Wide-field retinal mosaic image.
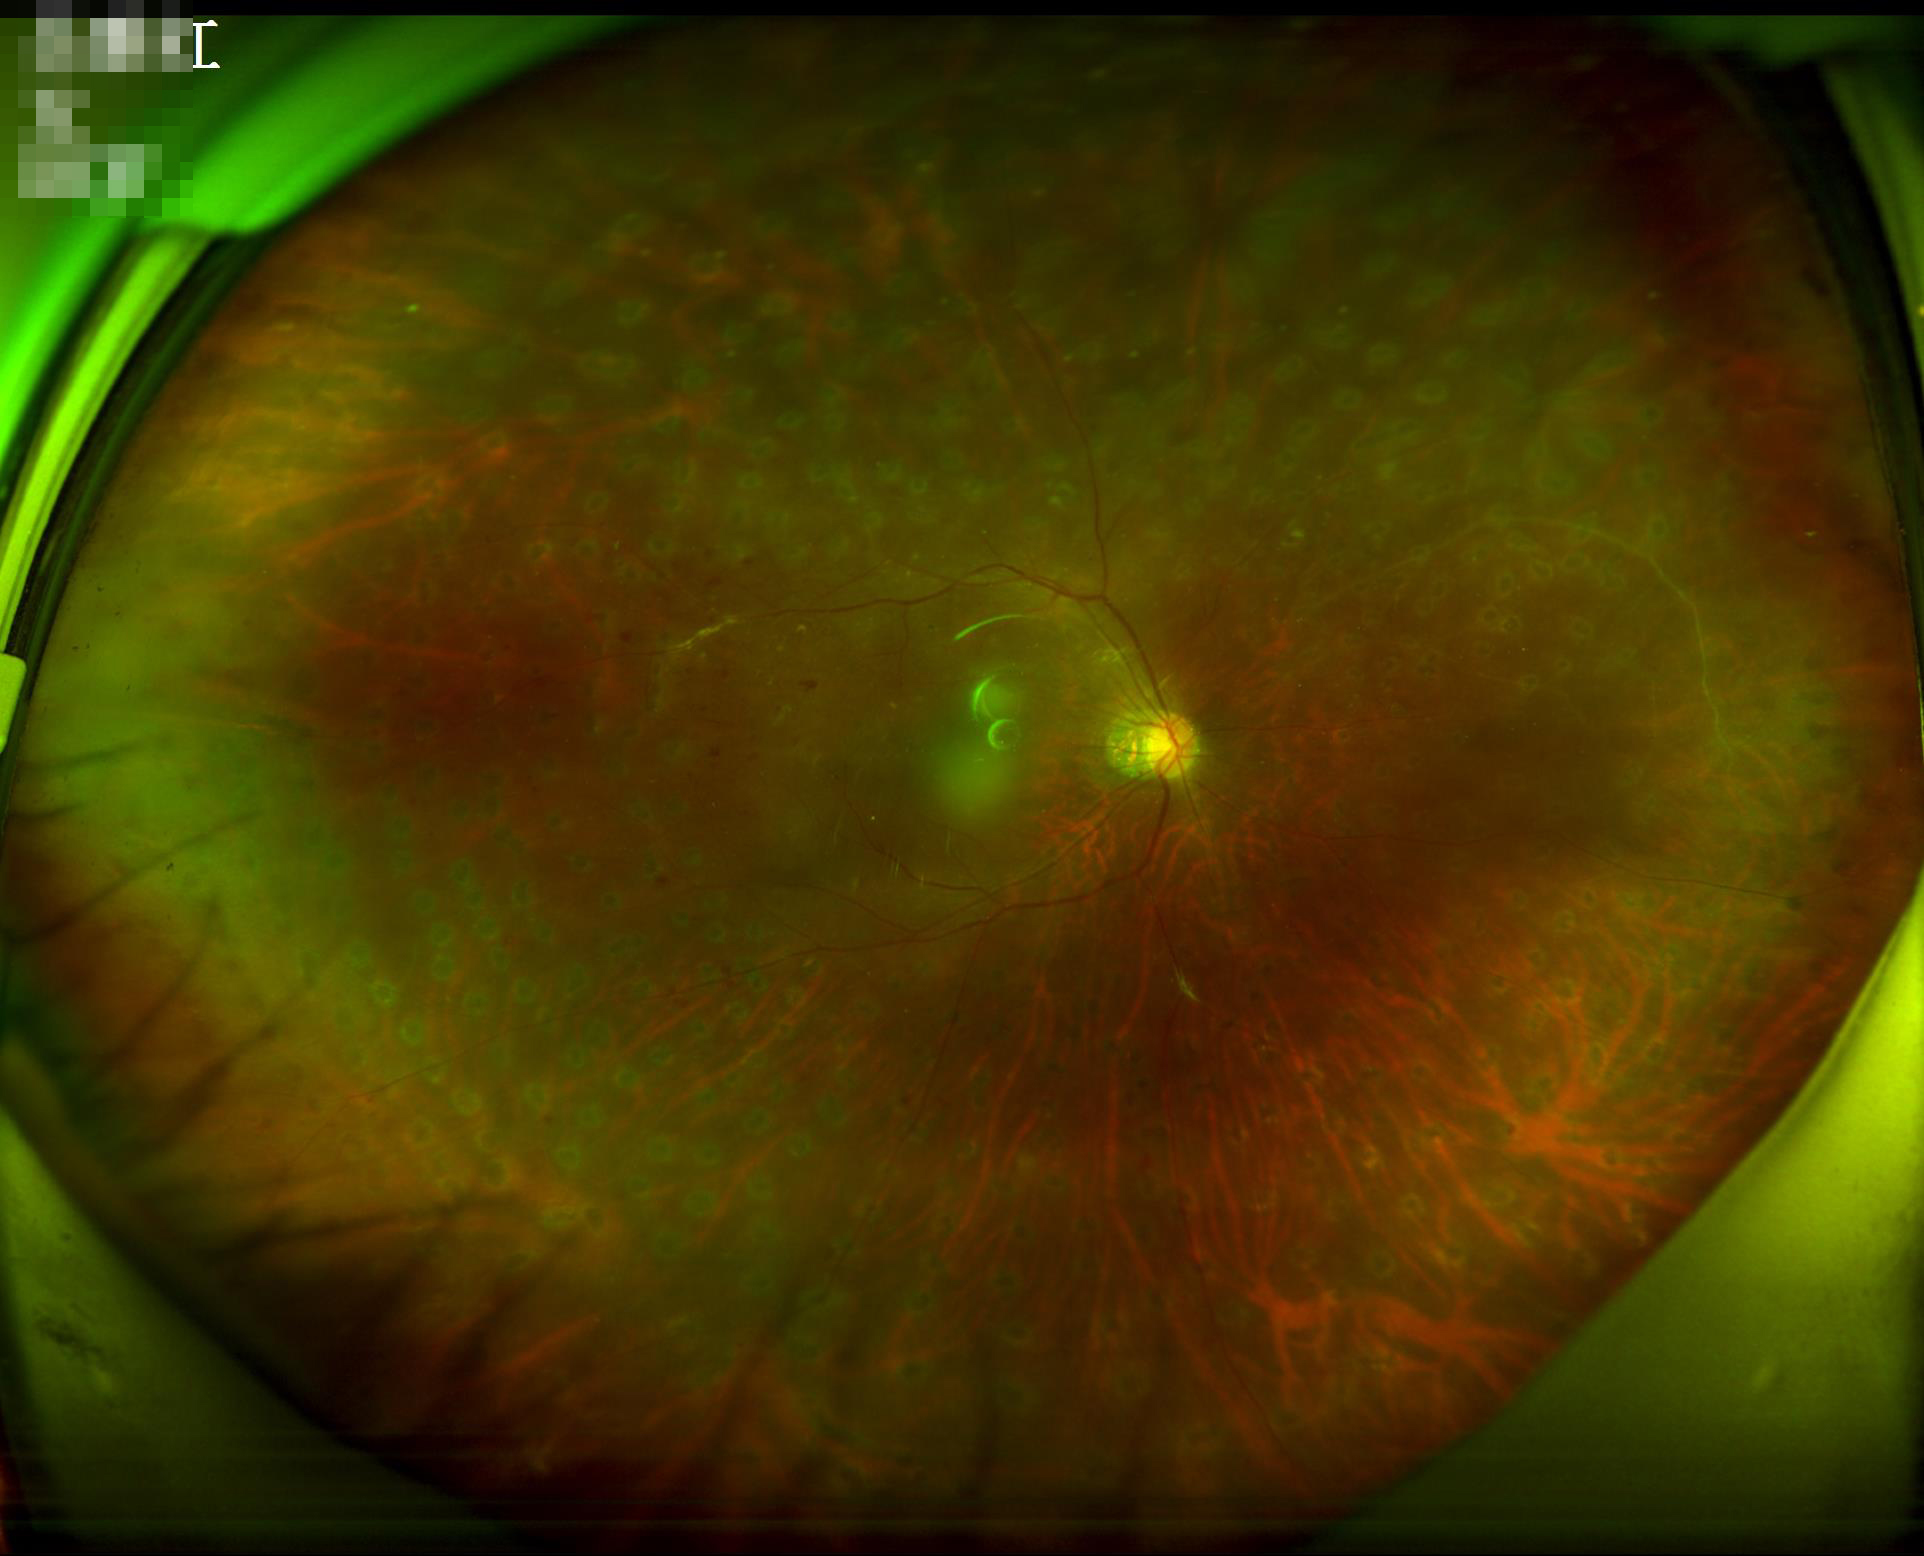

Overall image quality is poor. Contrast is low. No noticeable blur. Illumination is even.